Nonmydriatic fundus photograph. 45° field of view. Posterior pole color fundus photograph. 848 x 848 pixels.
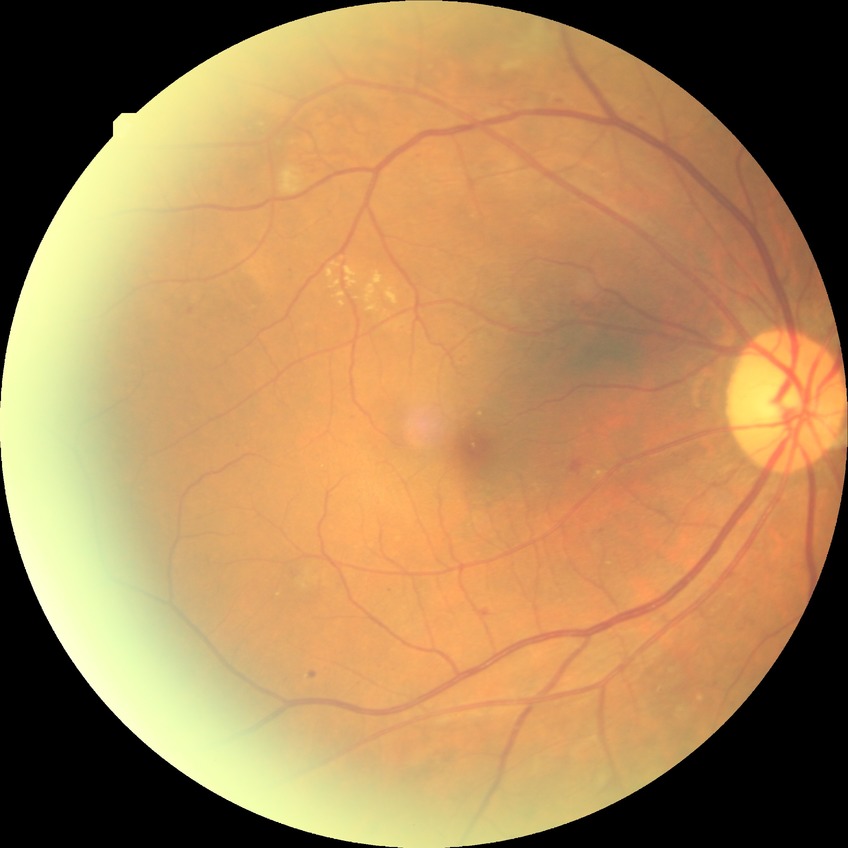
DR class: non-proliferative diabetic retinopathy. DR stage: PPDR.